CFP · 45-degree field of view:
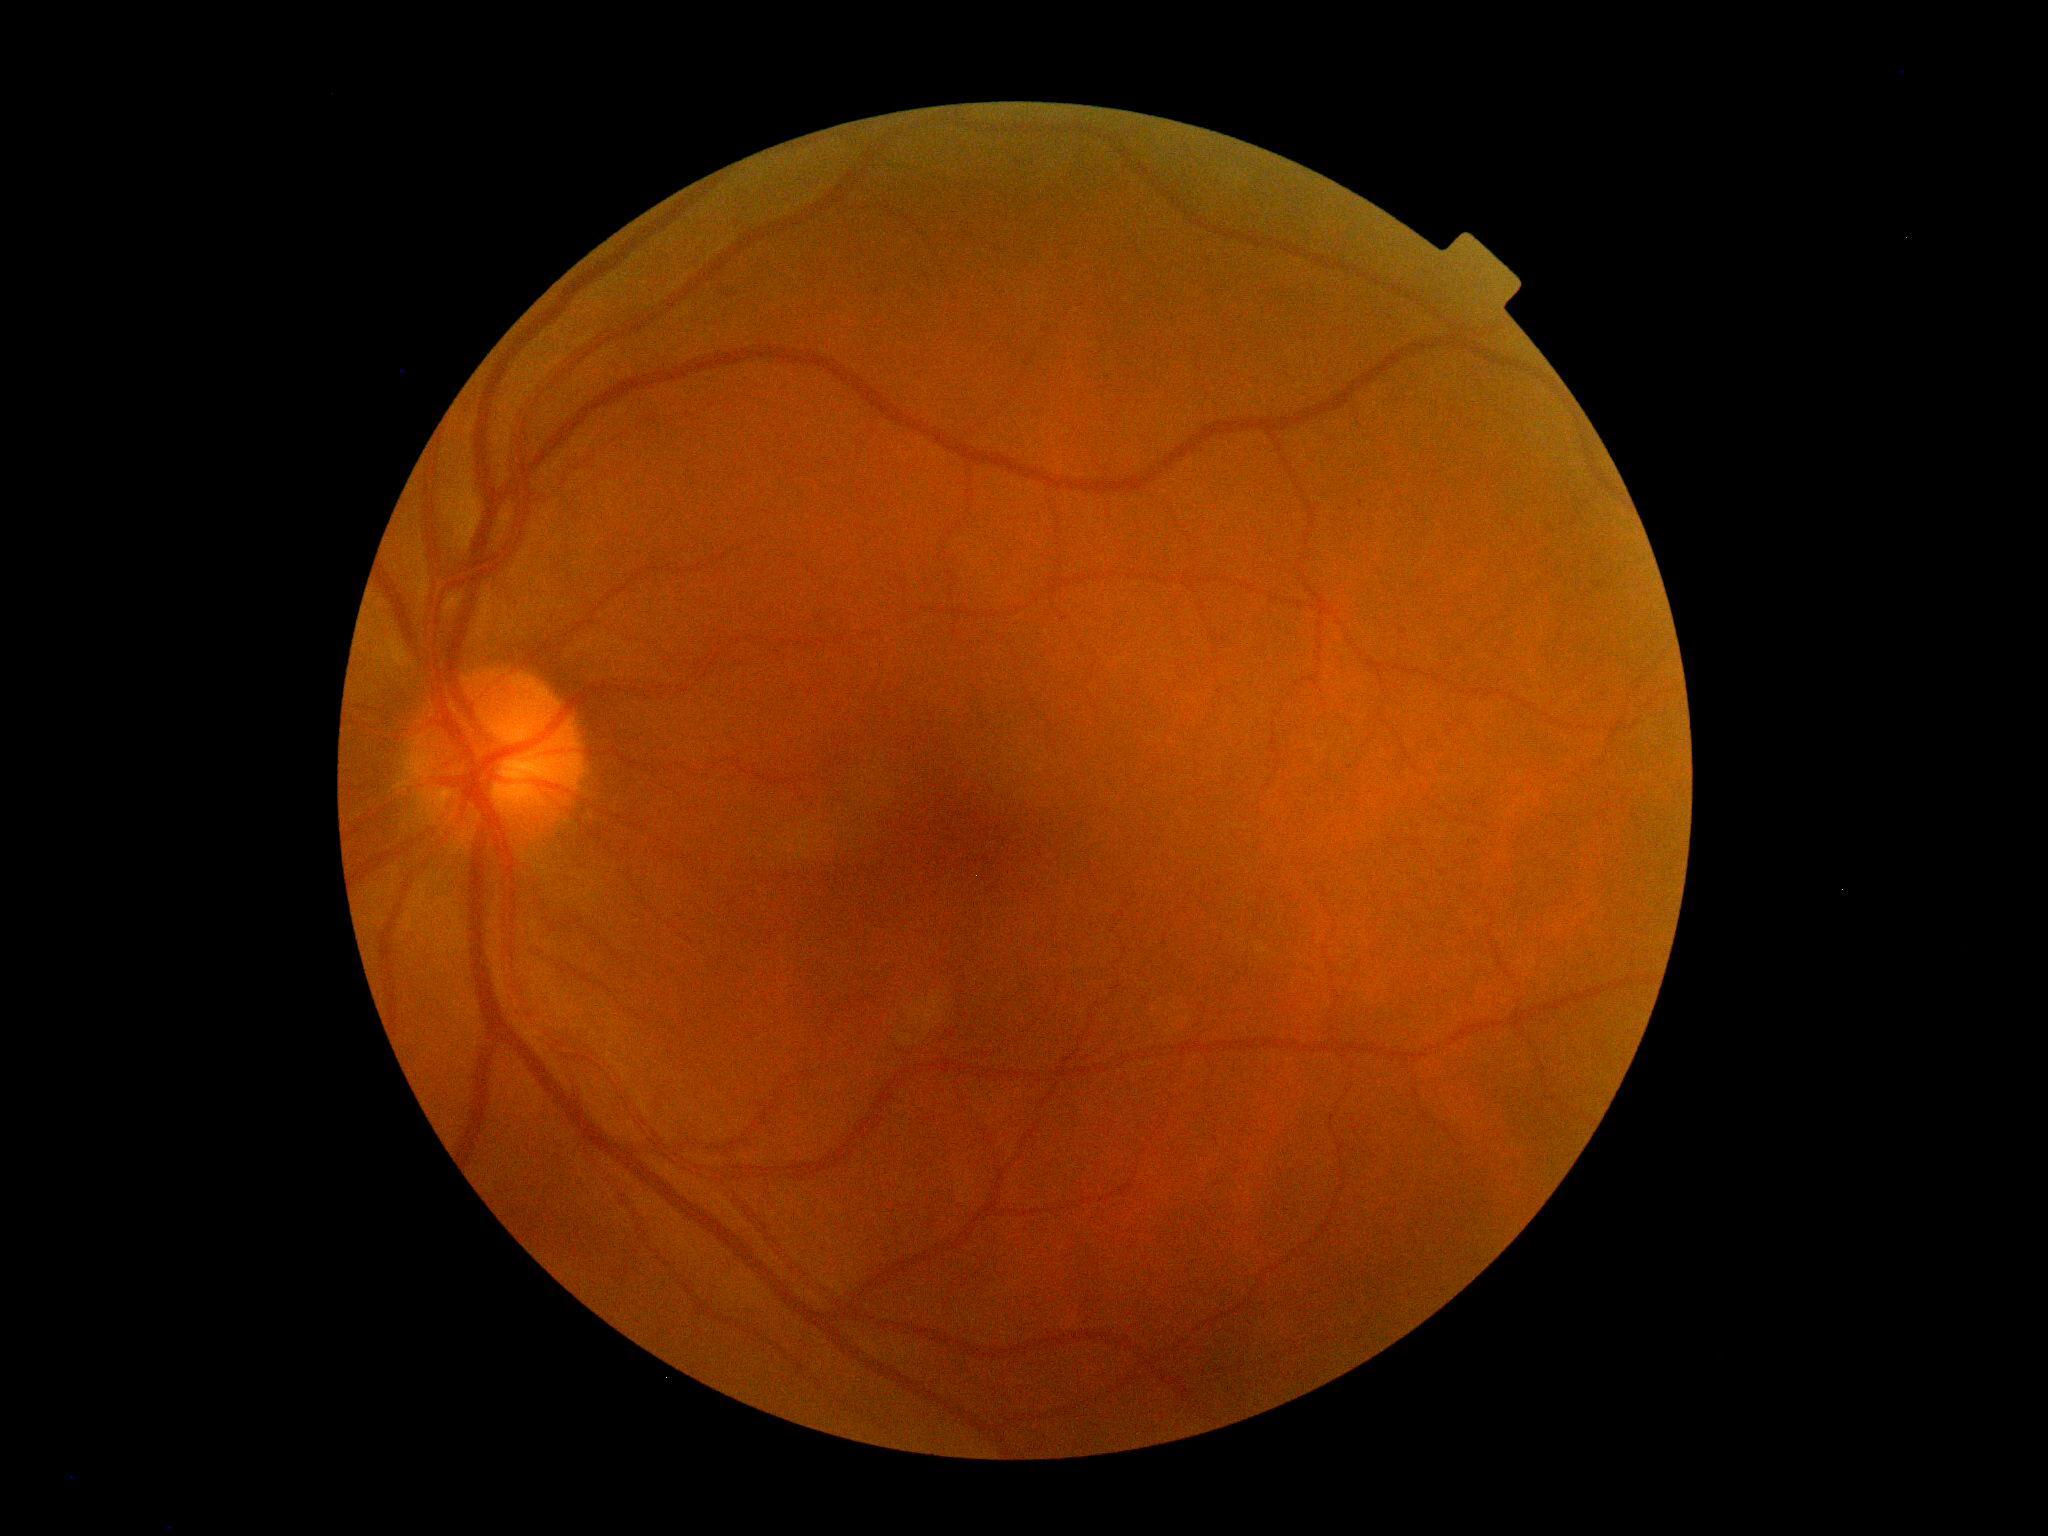
DR impression = no DR findings | retinopathy grade = 0 (no apparent retinopathy).